45° FOV — 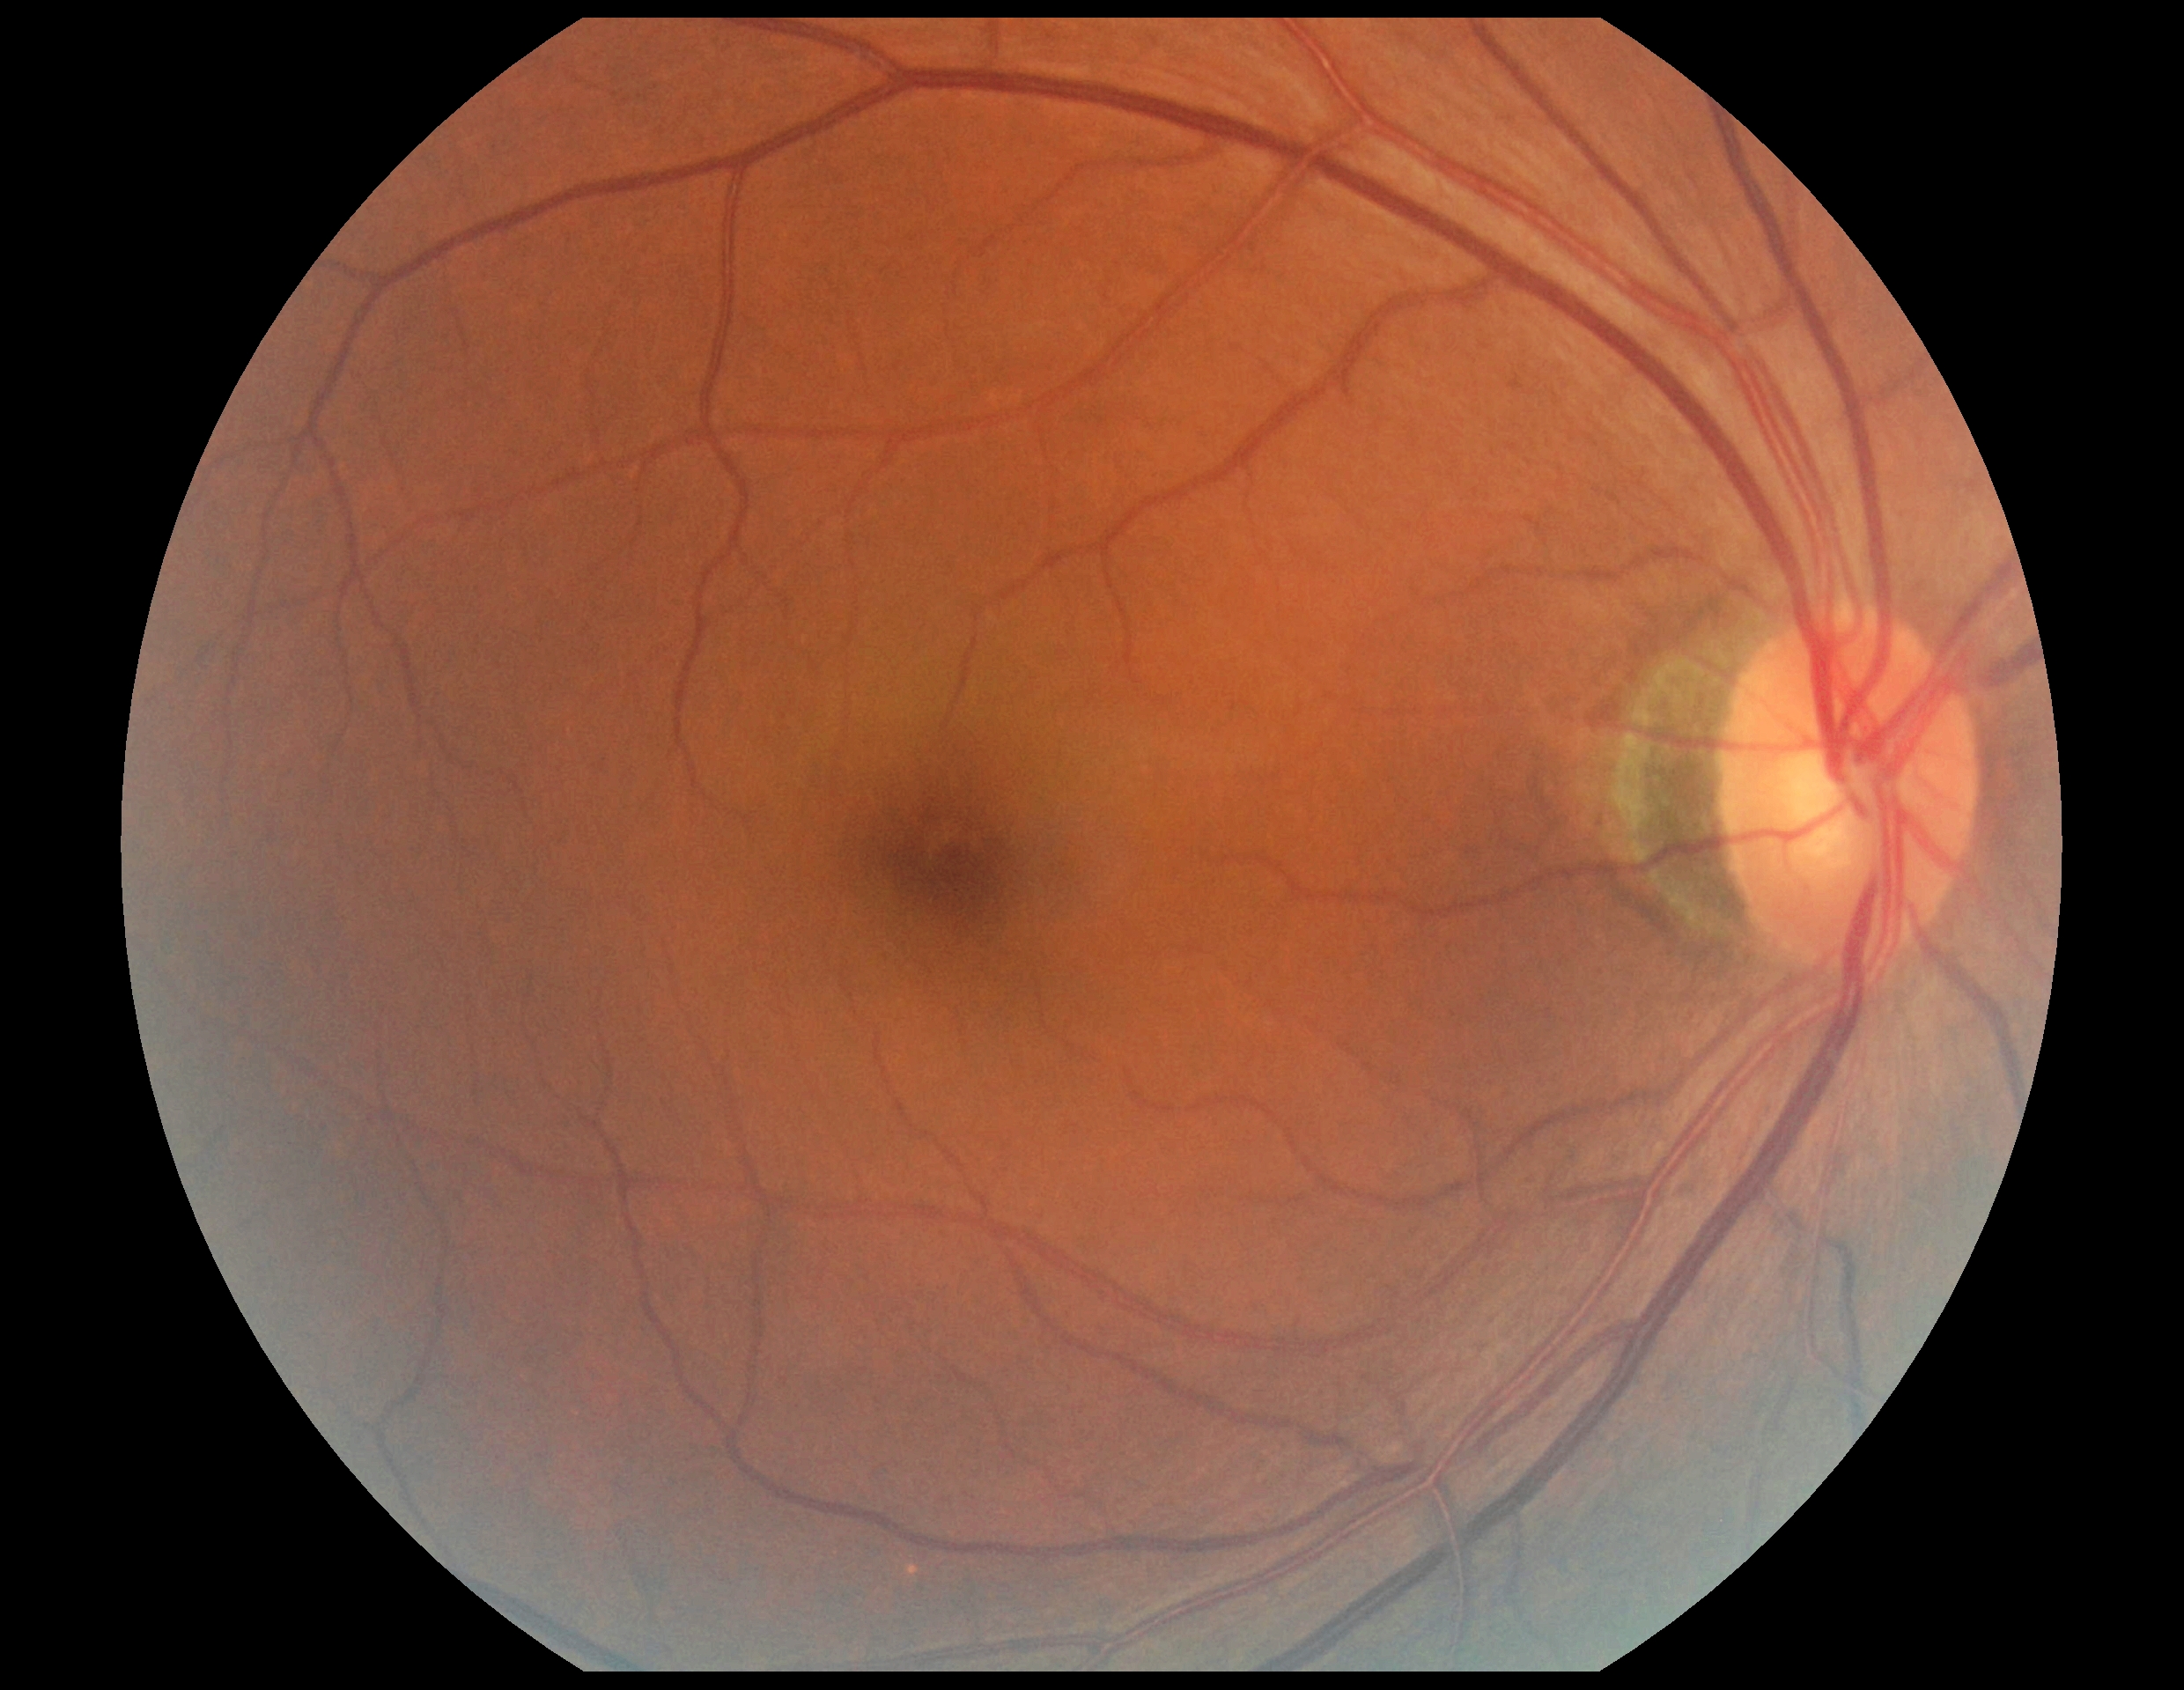 DR stage: 0.